2212x1659px — 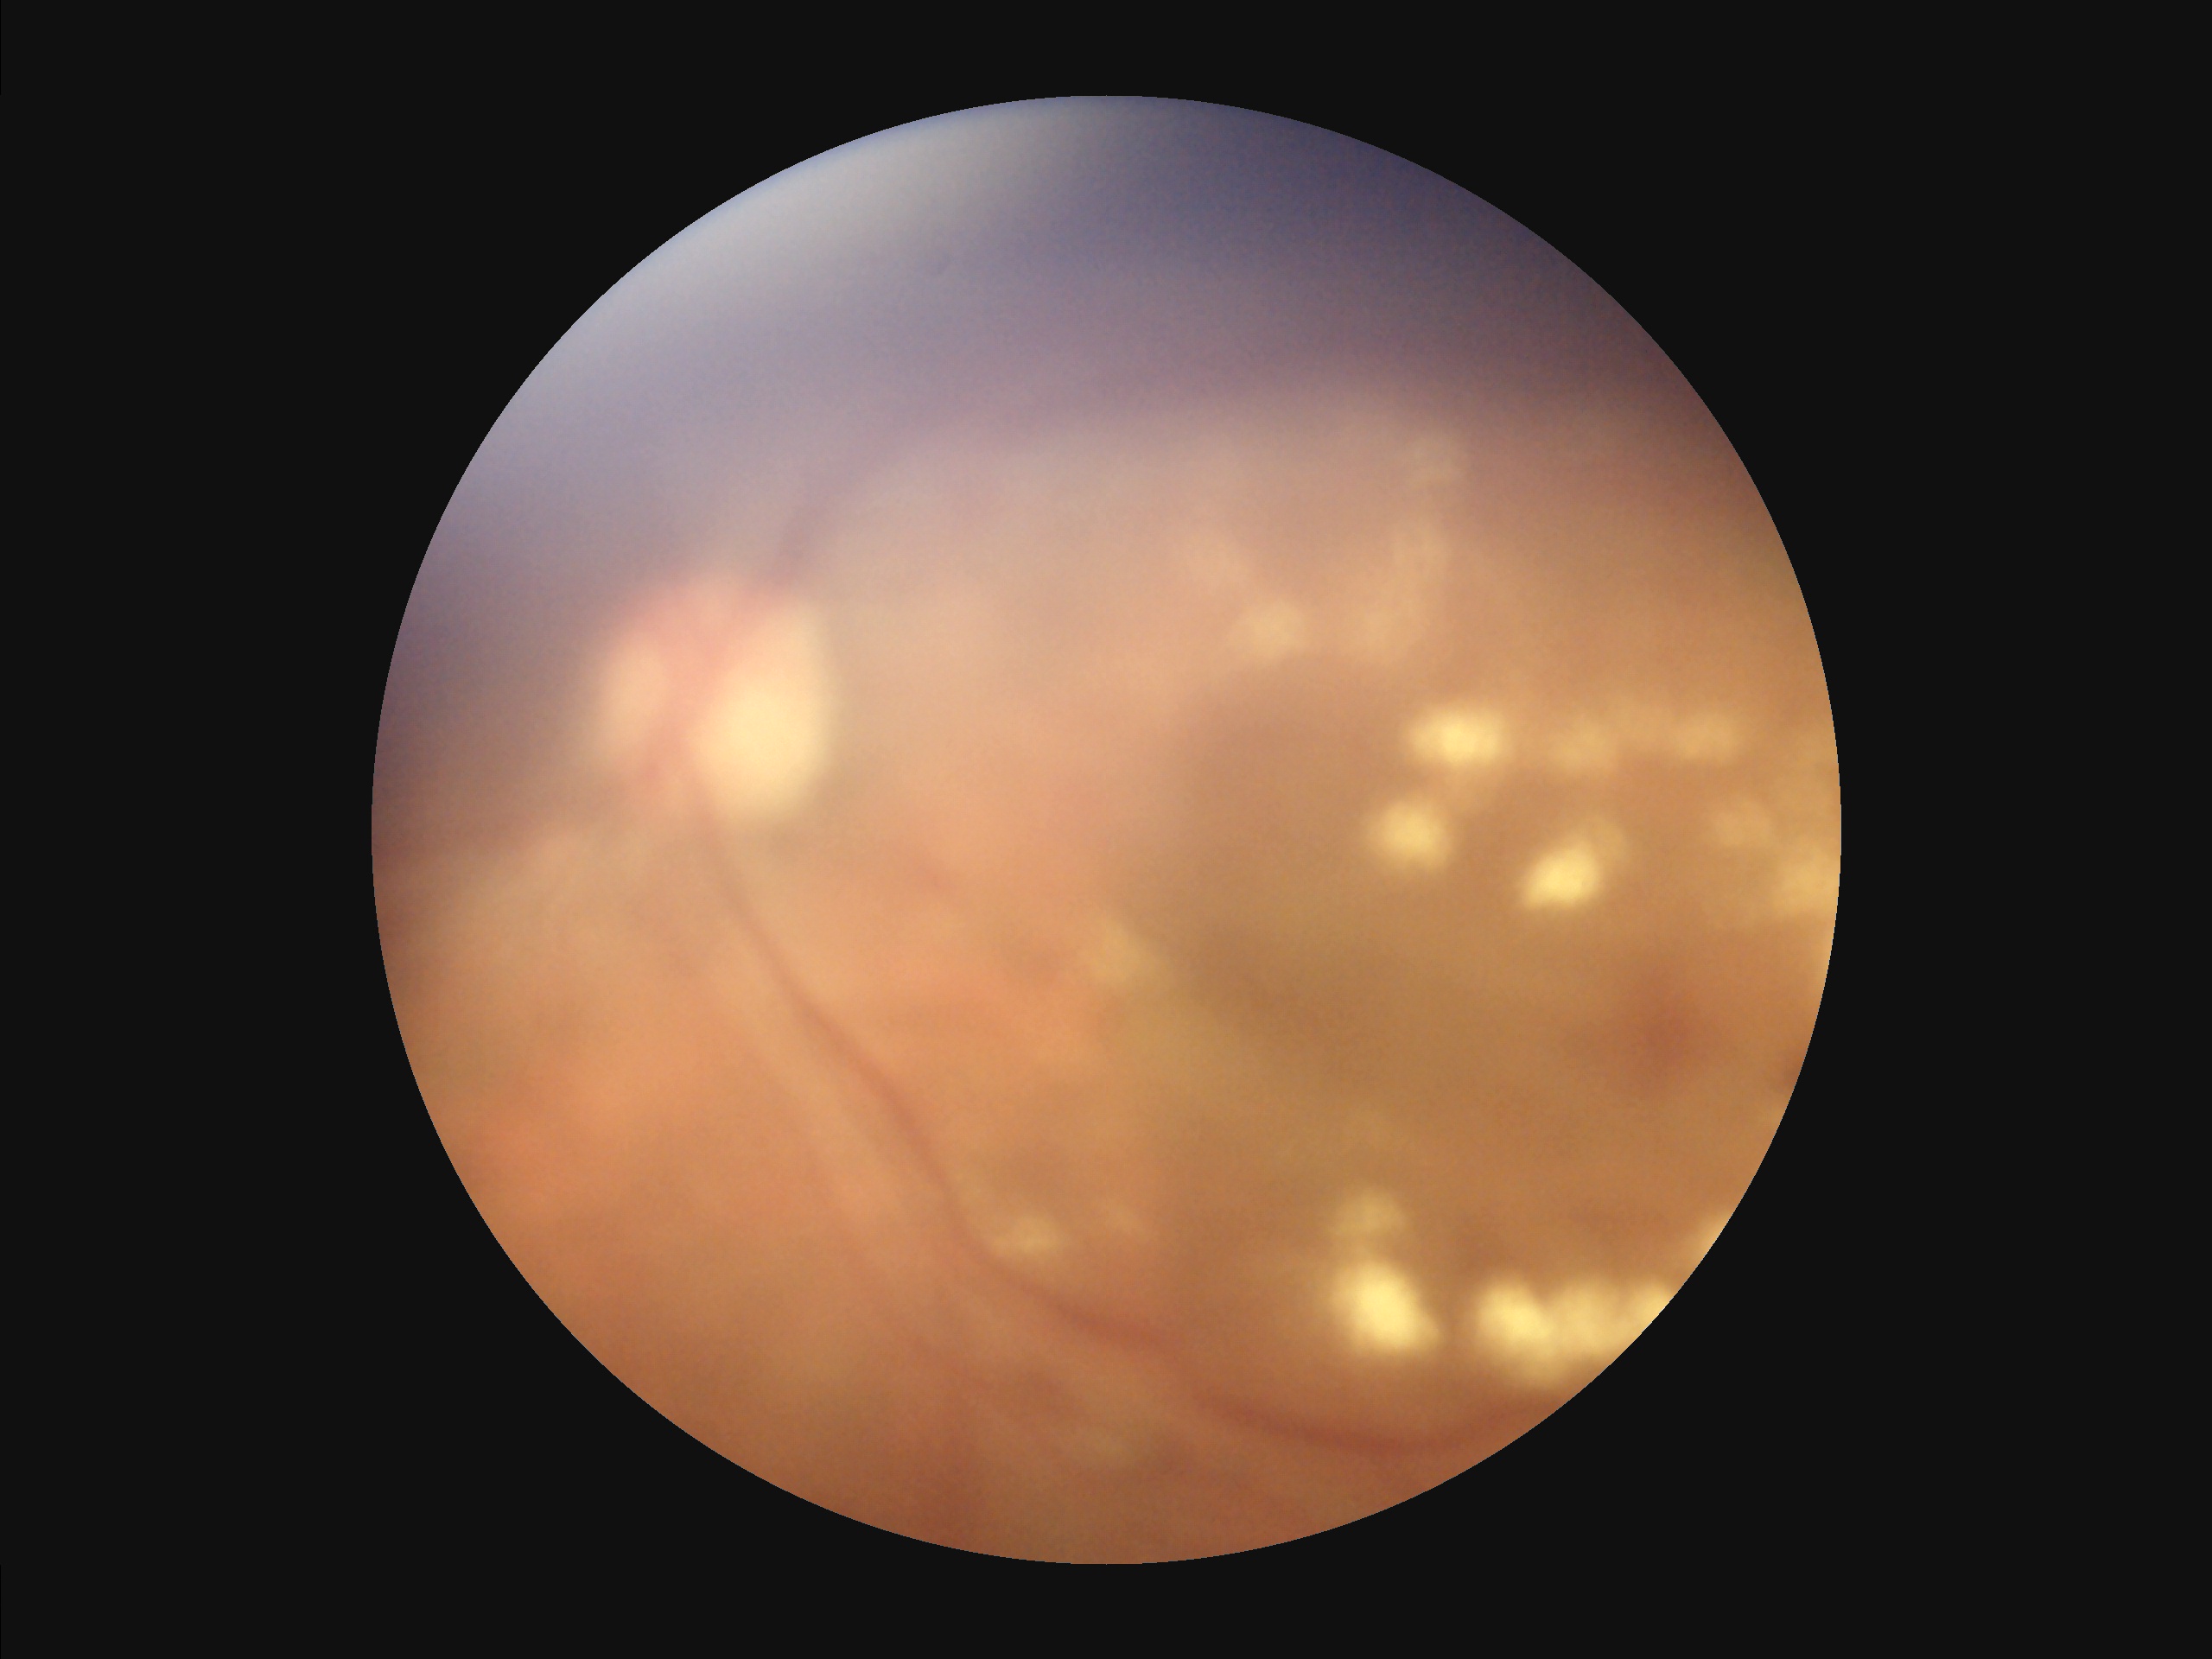
Image quality is suboptimal.
Vessels and details are hard to distinguish.
There is over- or under-exposure or a color cast.
Noticeable blur in the optic disc, vessels, or background.